Field includes the optic disc and macula
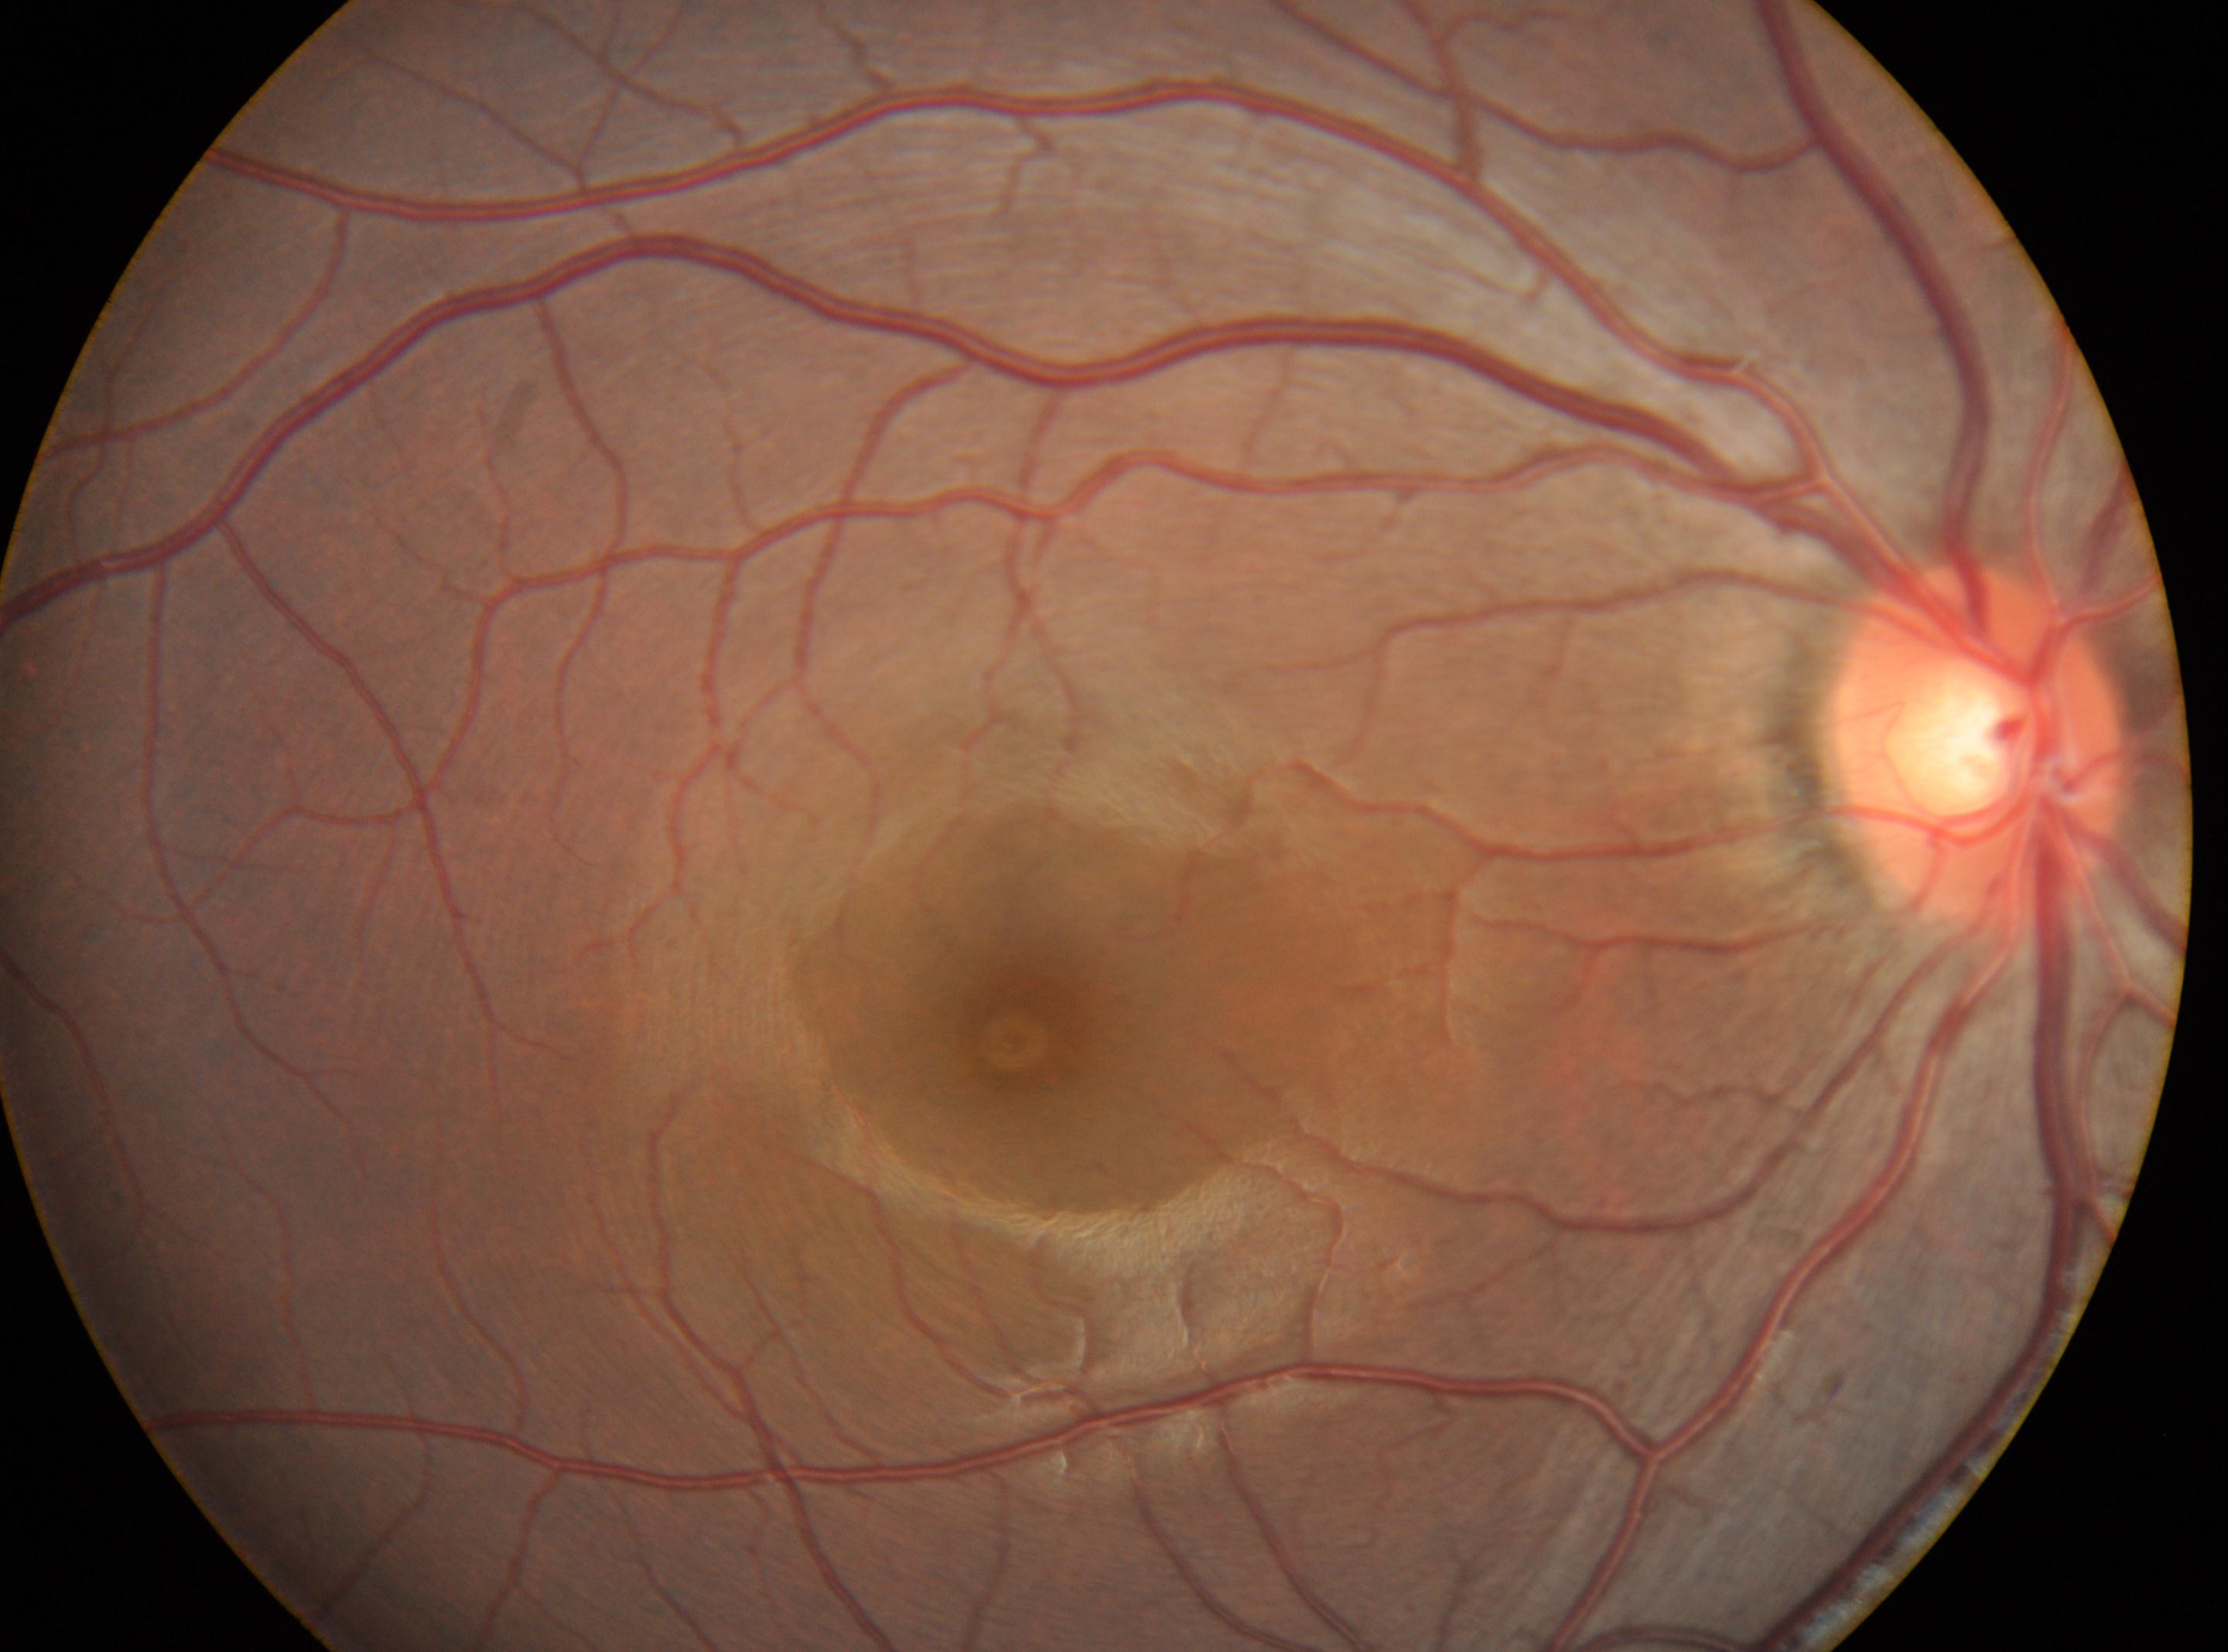 {
  "fovea": "[1024, 1041]",
  "eye": "oculus dexter",
  "dr_grade": "0 (no apparent retinopathy) — no visible signs of diabetic retinopathy",
  "optic_disc": "[1981, 741]"
}